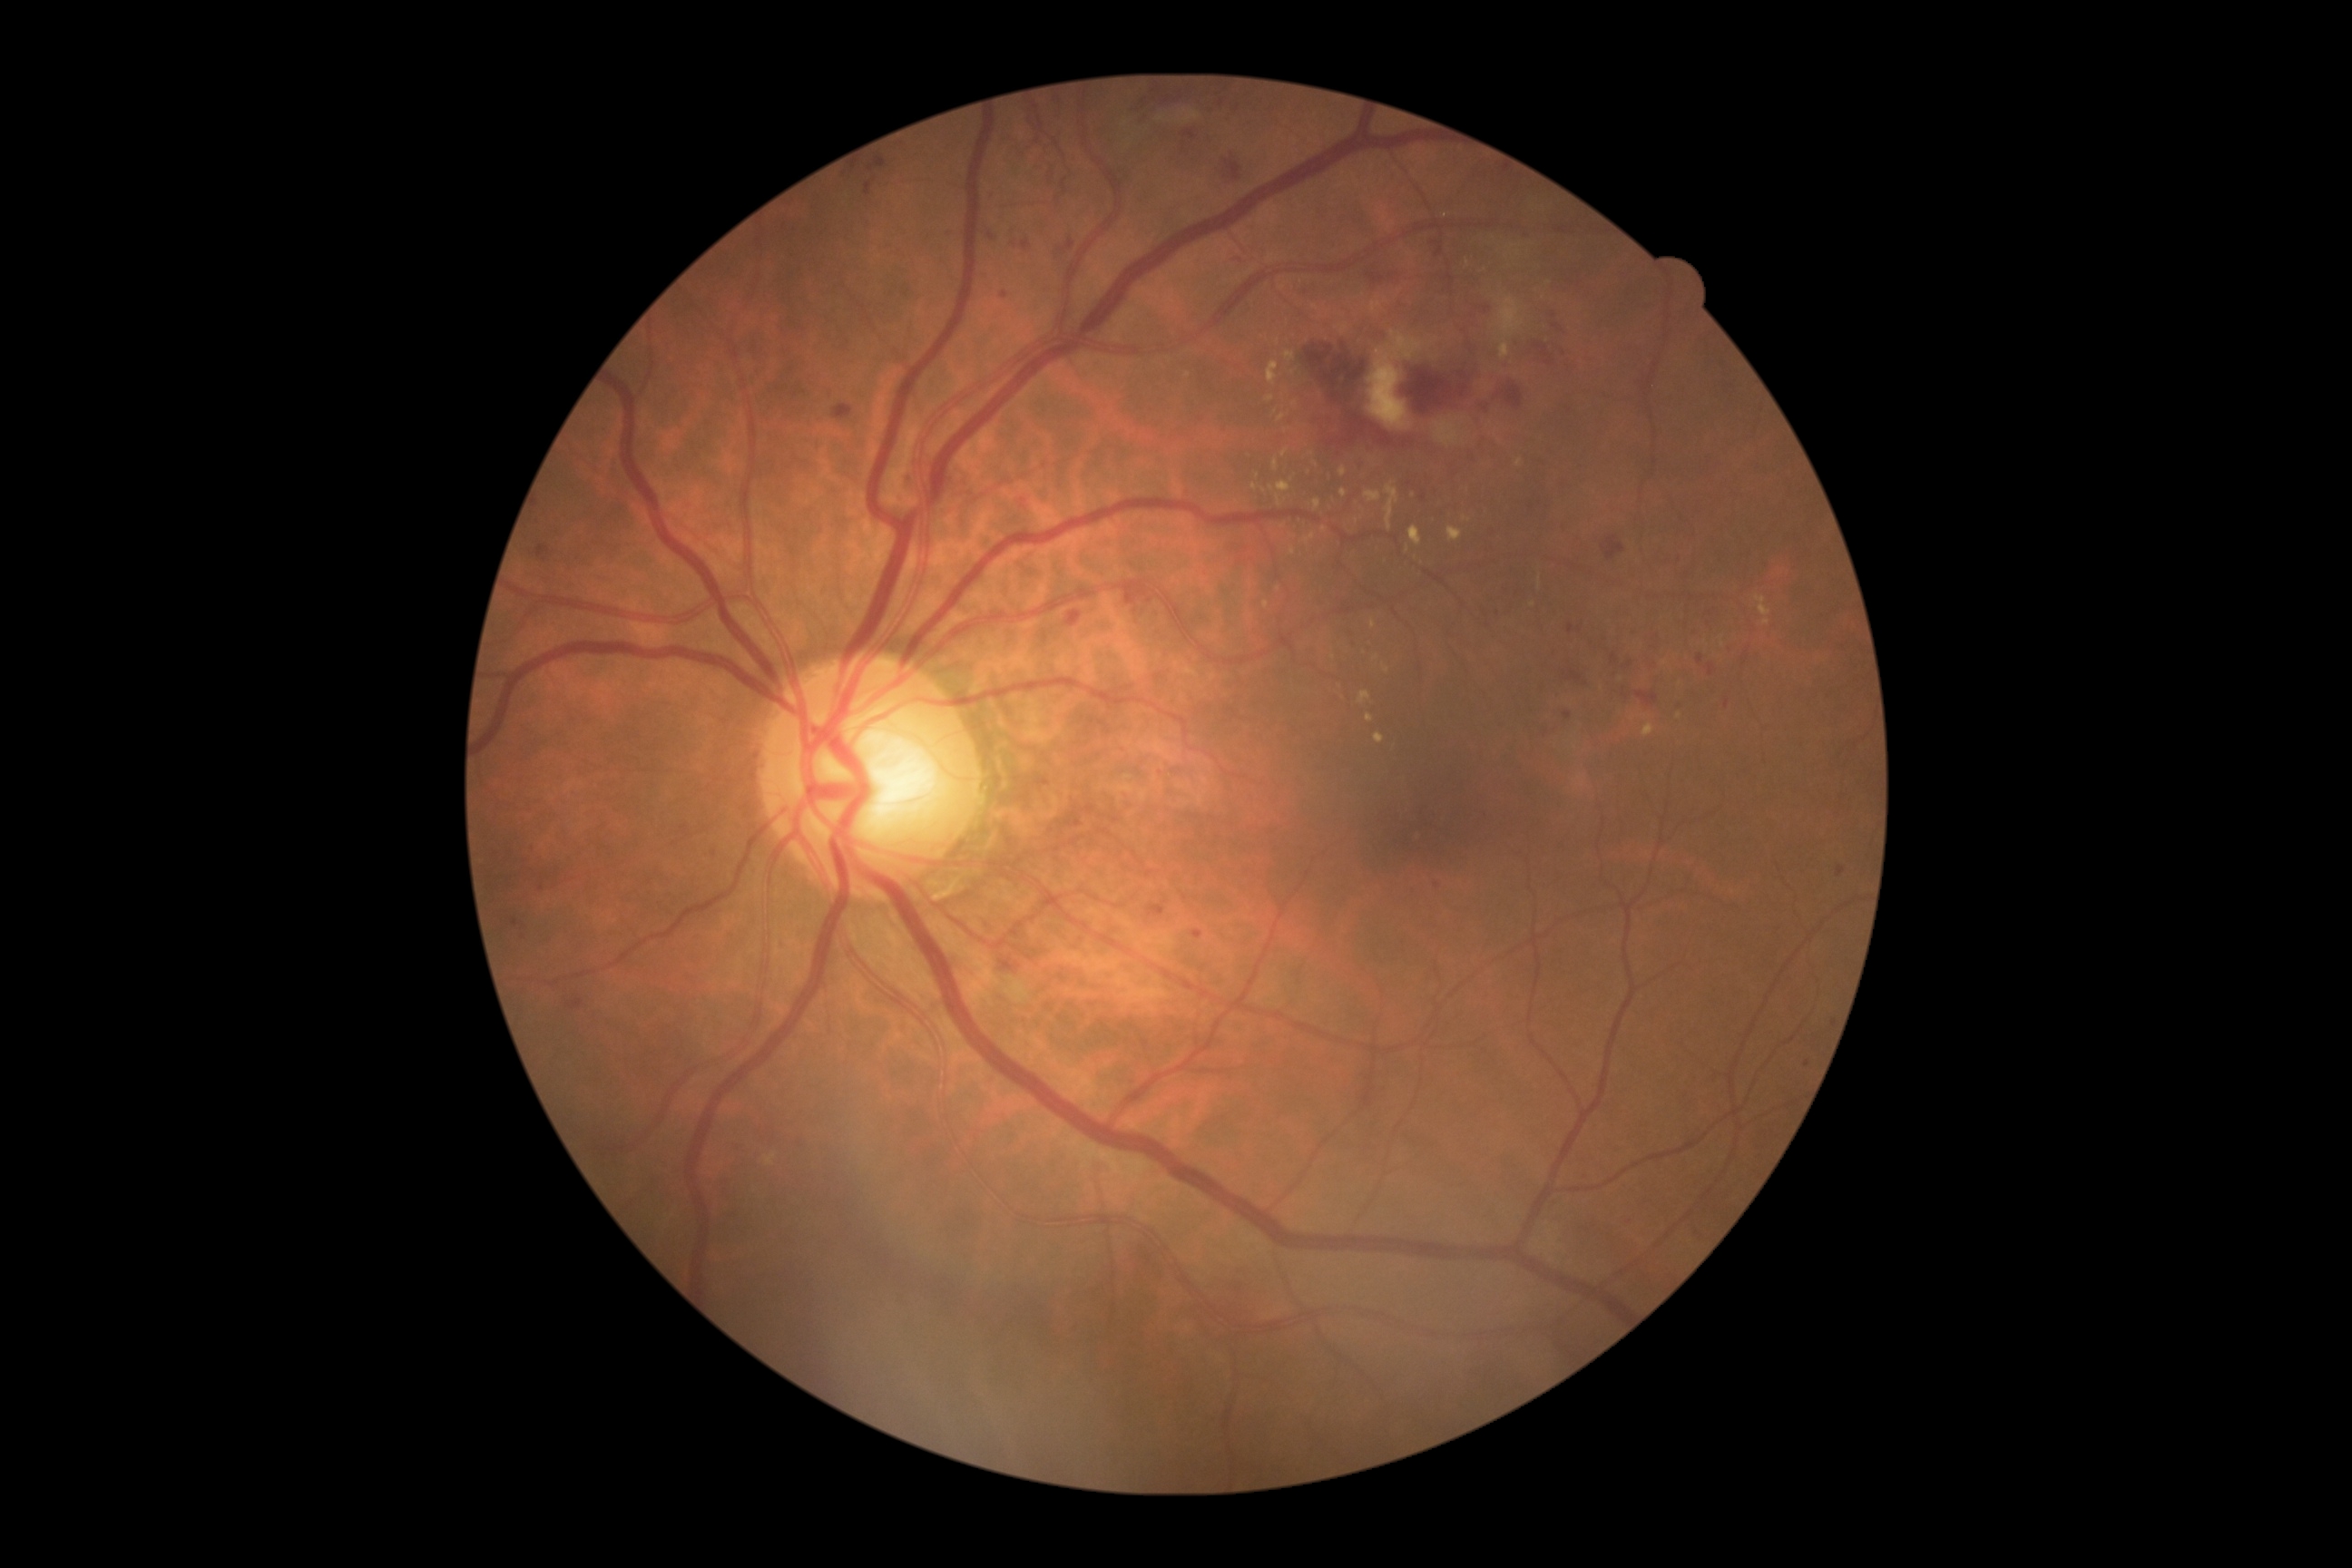 DR is grade 3 (severe NPDR).